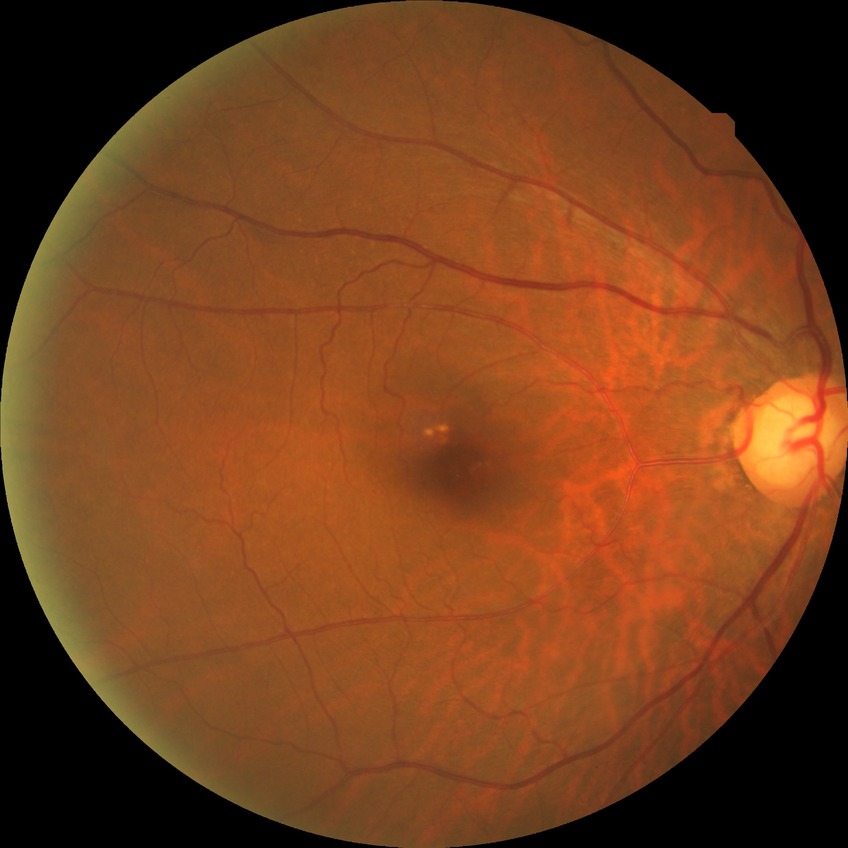 Assessment:
- diabetic retinopathy (DR): no diabetic retinopathy (NDR)